Davis DR grading — 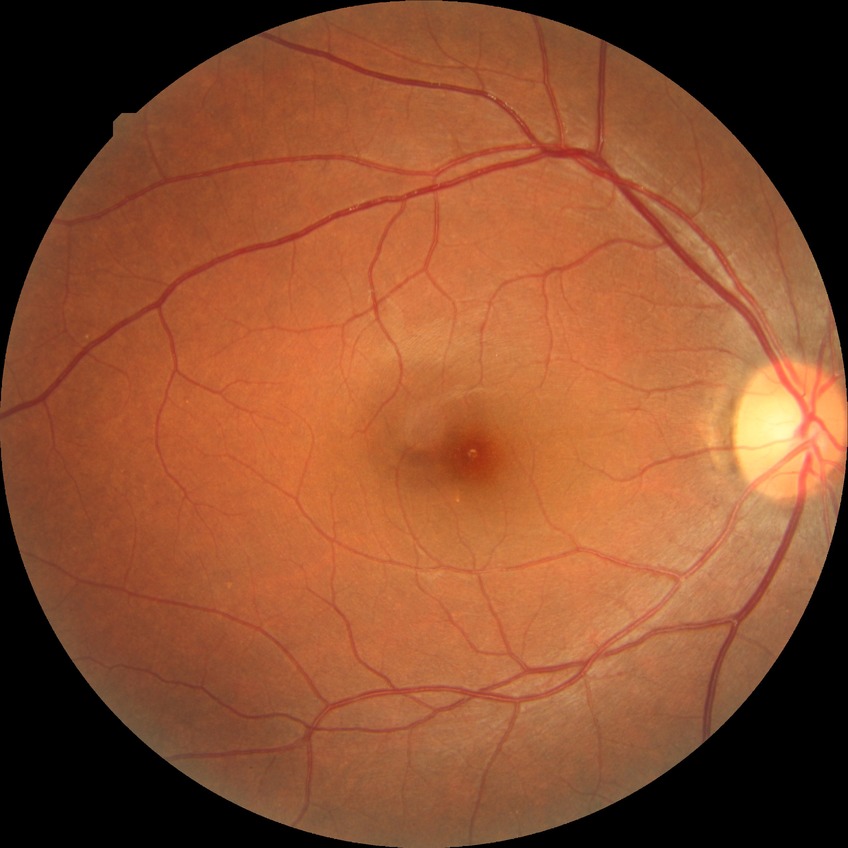 Diabetic retinopathy (DR): NDR (no diabetic retinopathy).